Color fundus image. 2048 by 1536 pixels: 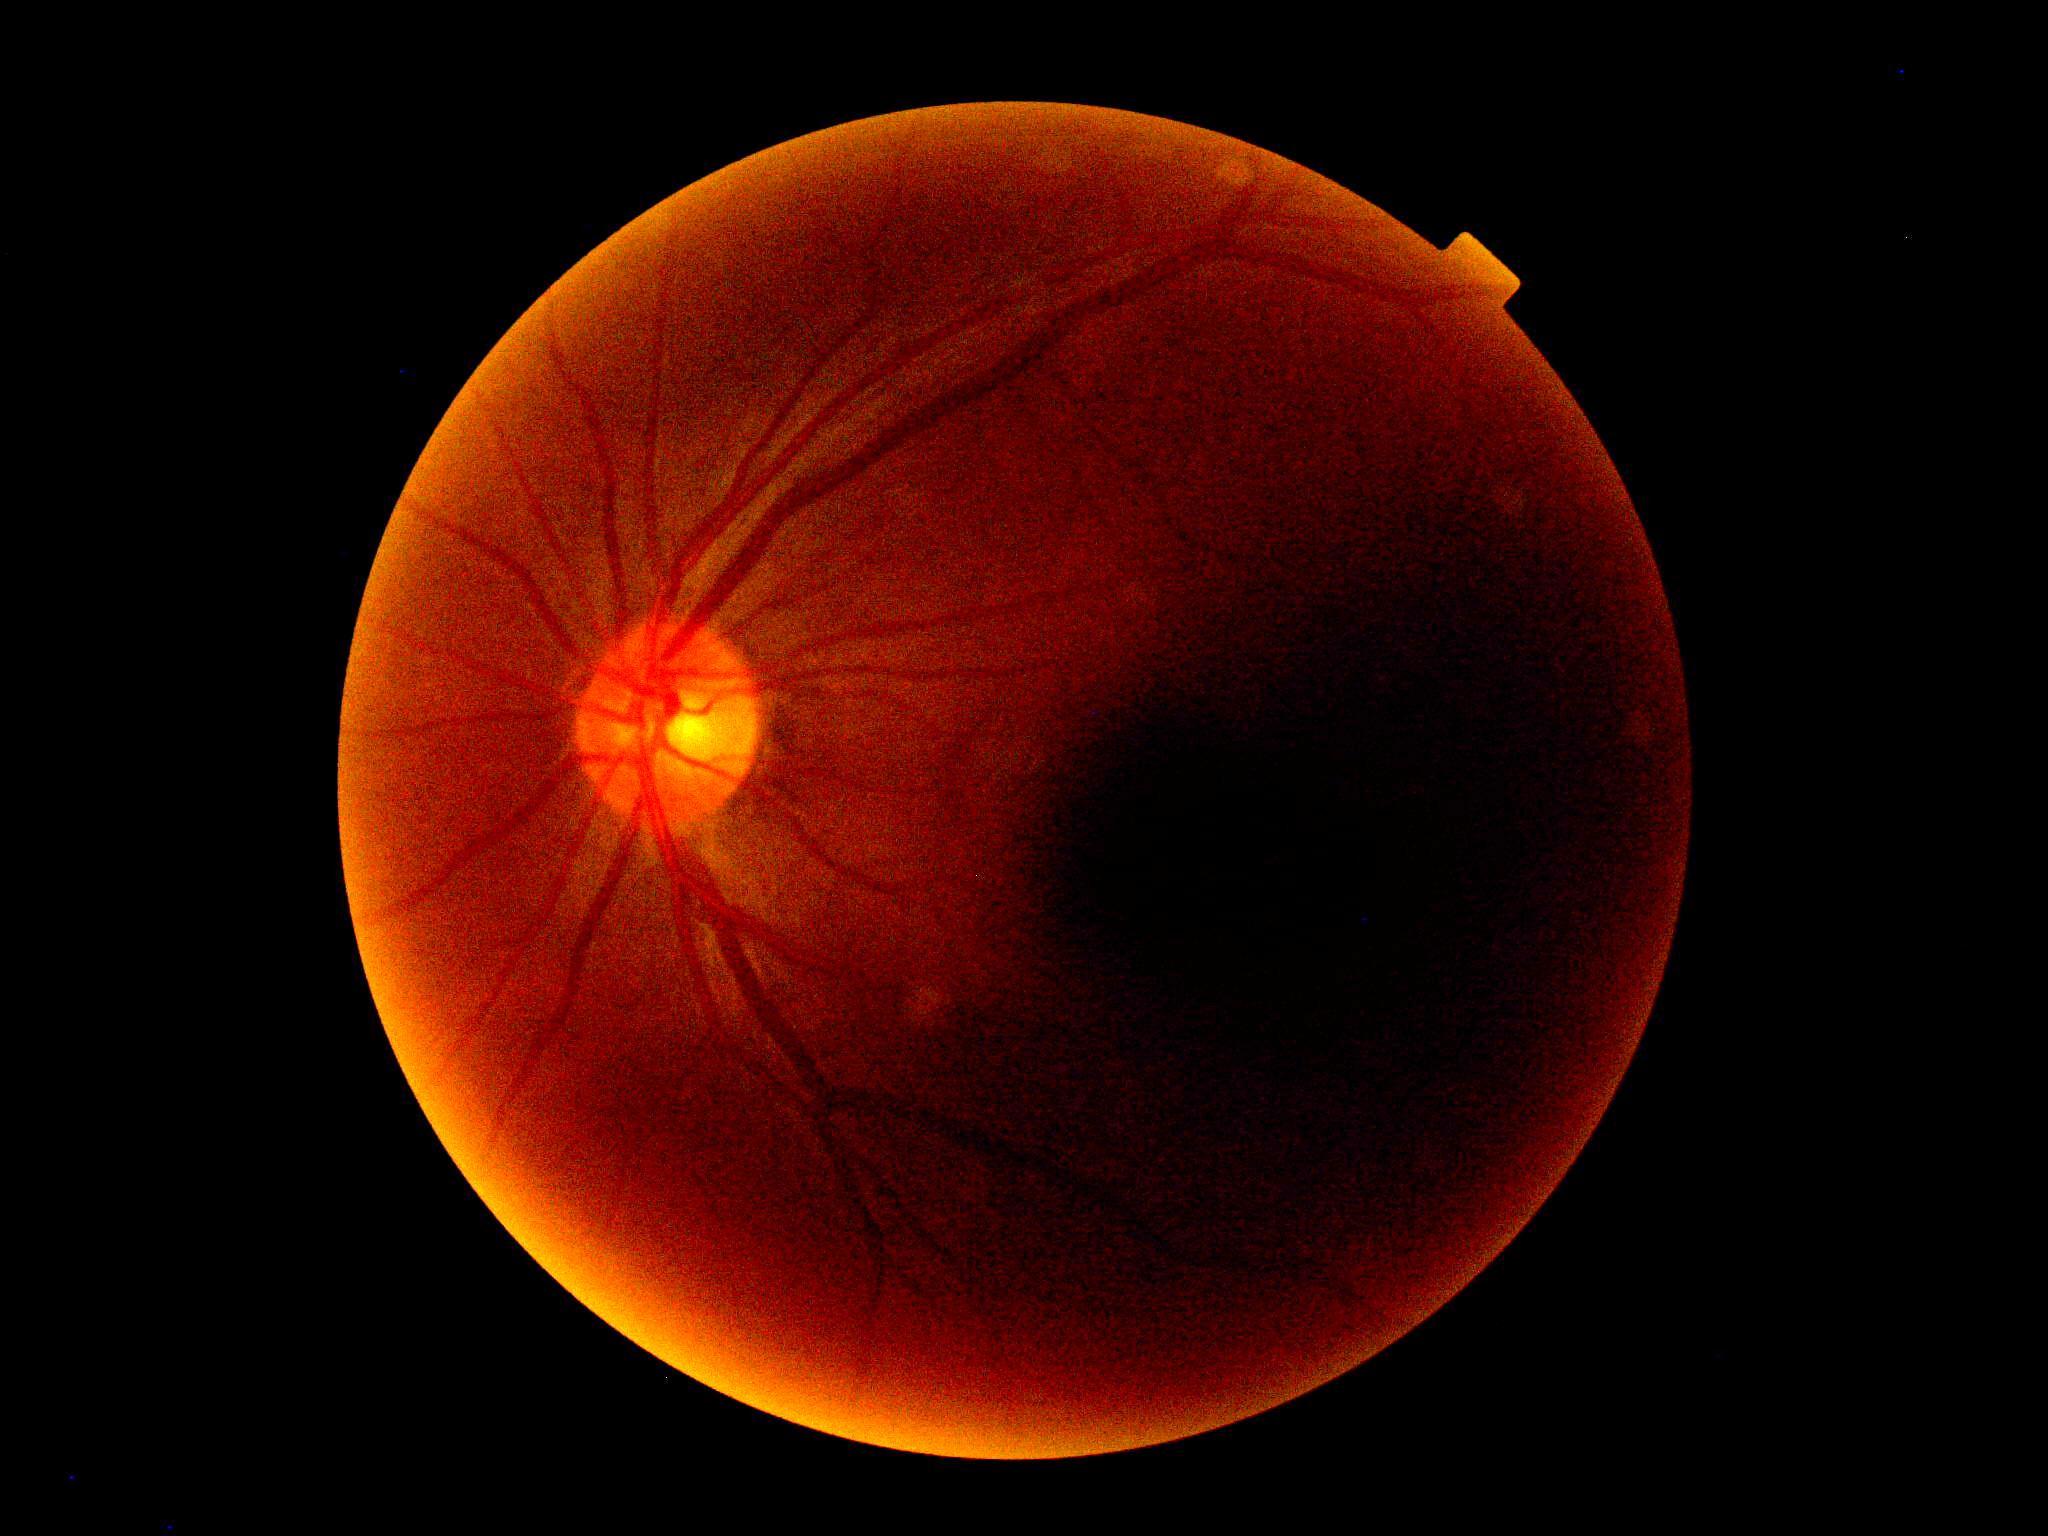 Annotations:
– diabetic retinopathy — ungradable due to poor image quality